Color fundus image · Nidek AFC-330 · optic disc-centered crop: 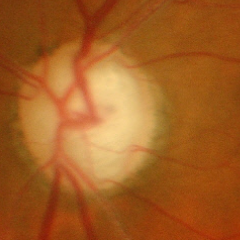 There is evidence of advanced glaucoma.